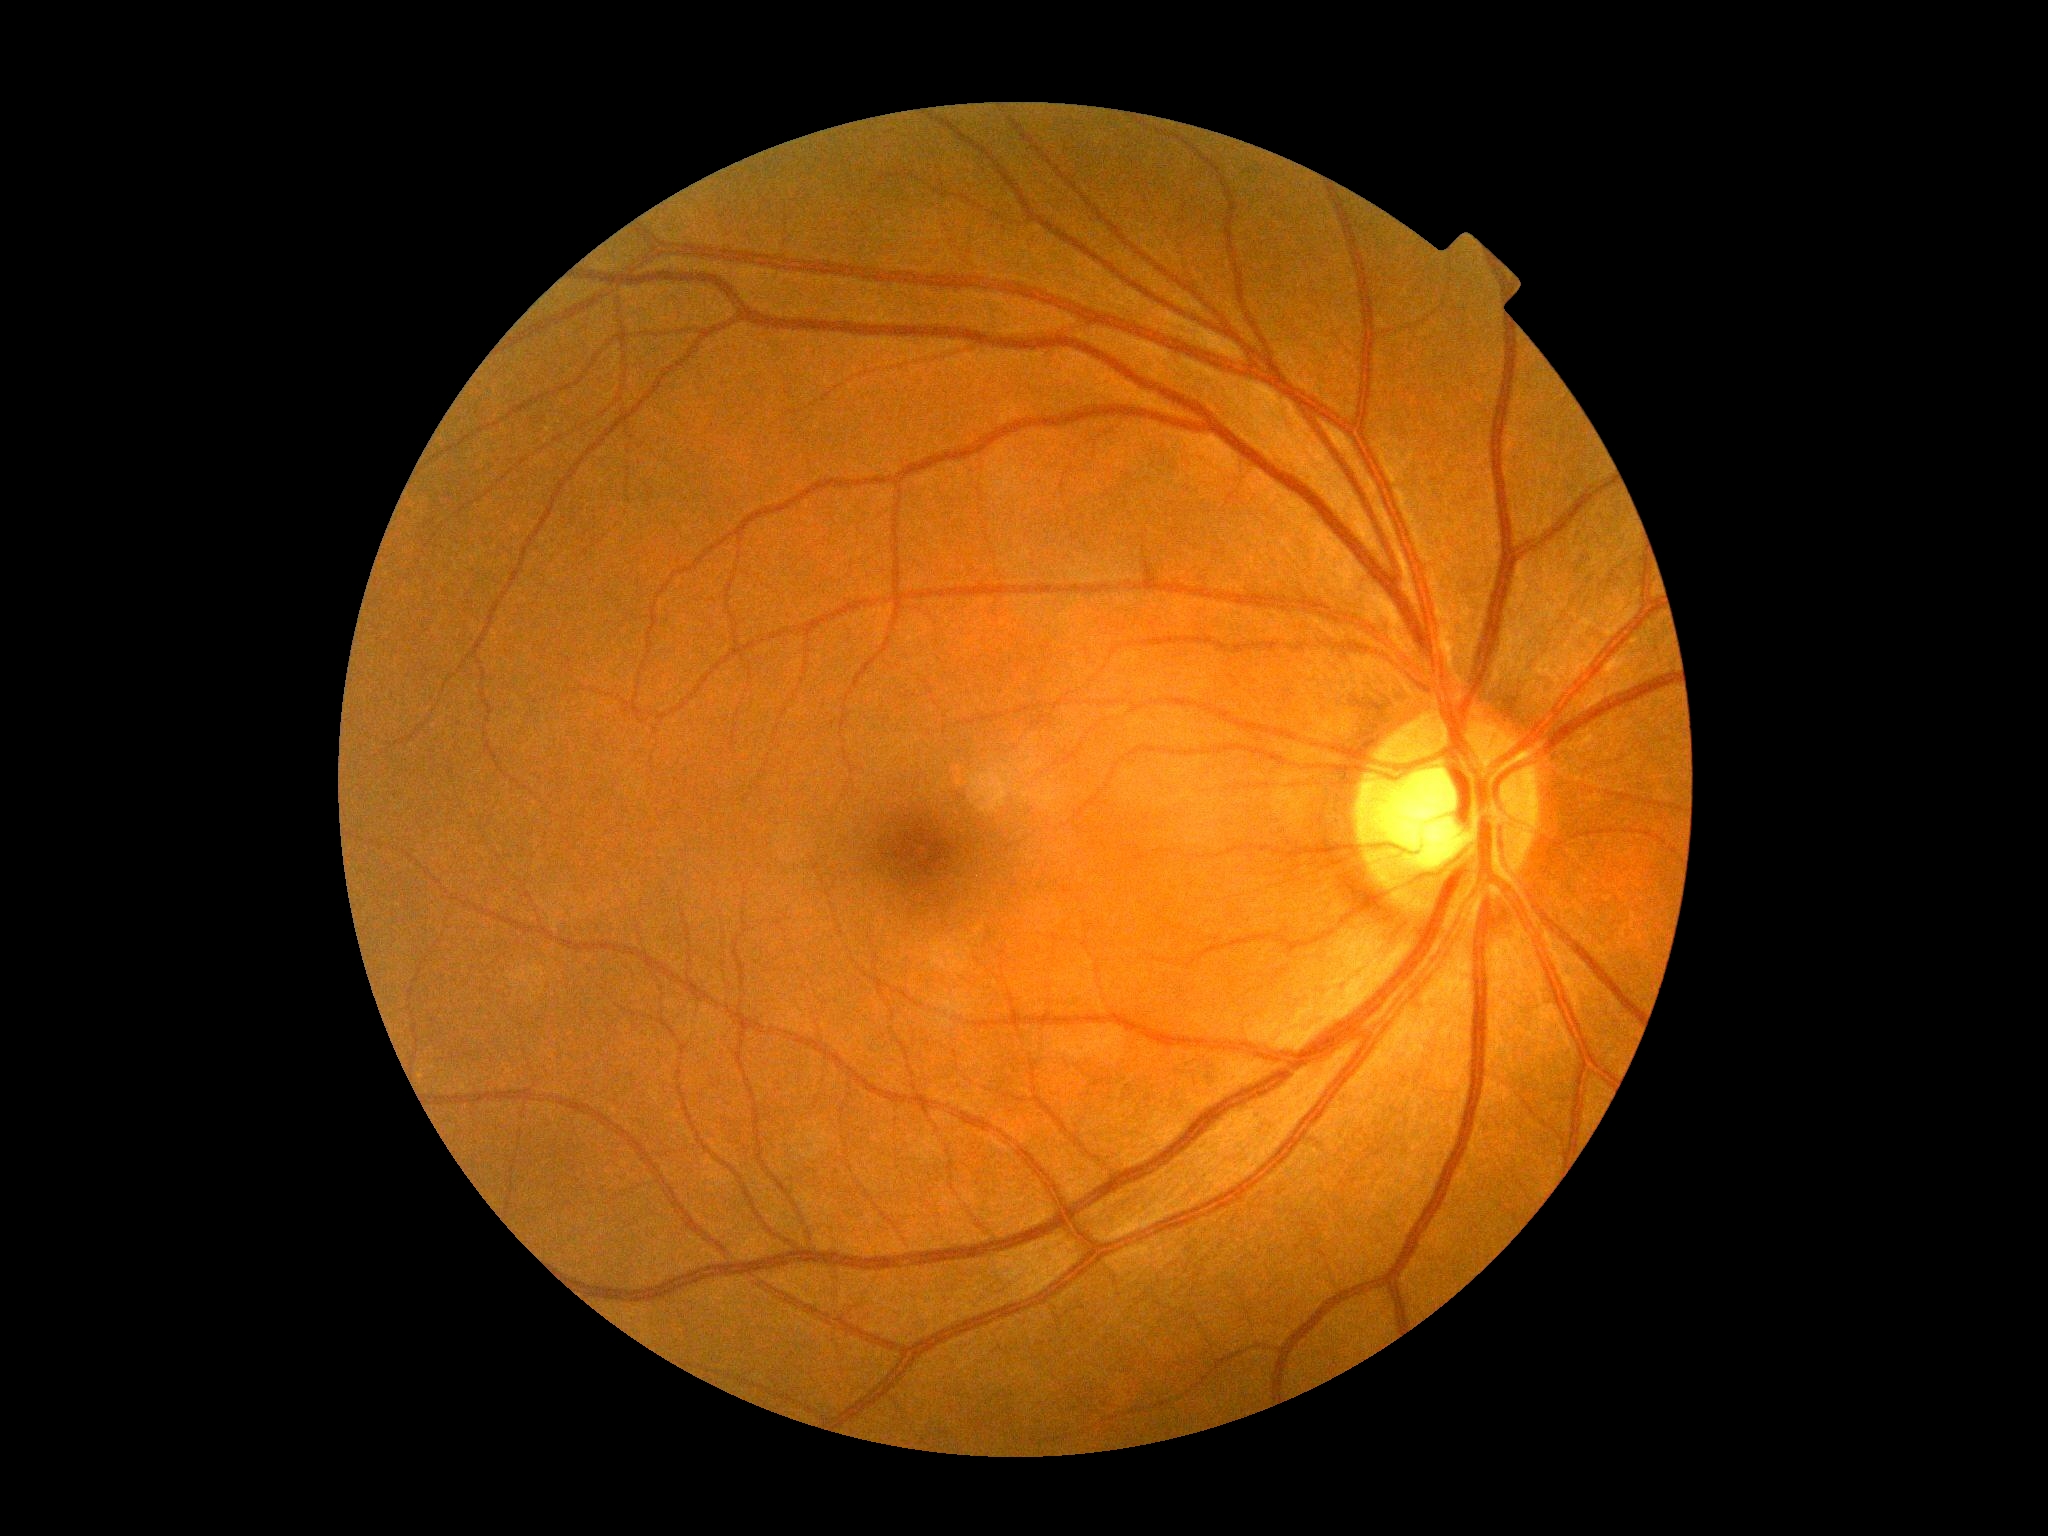

DR grade is no apparent diabetic retinopathy (0). No apparent diabetic retinopathy.